848x848, Davis DR grading.
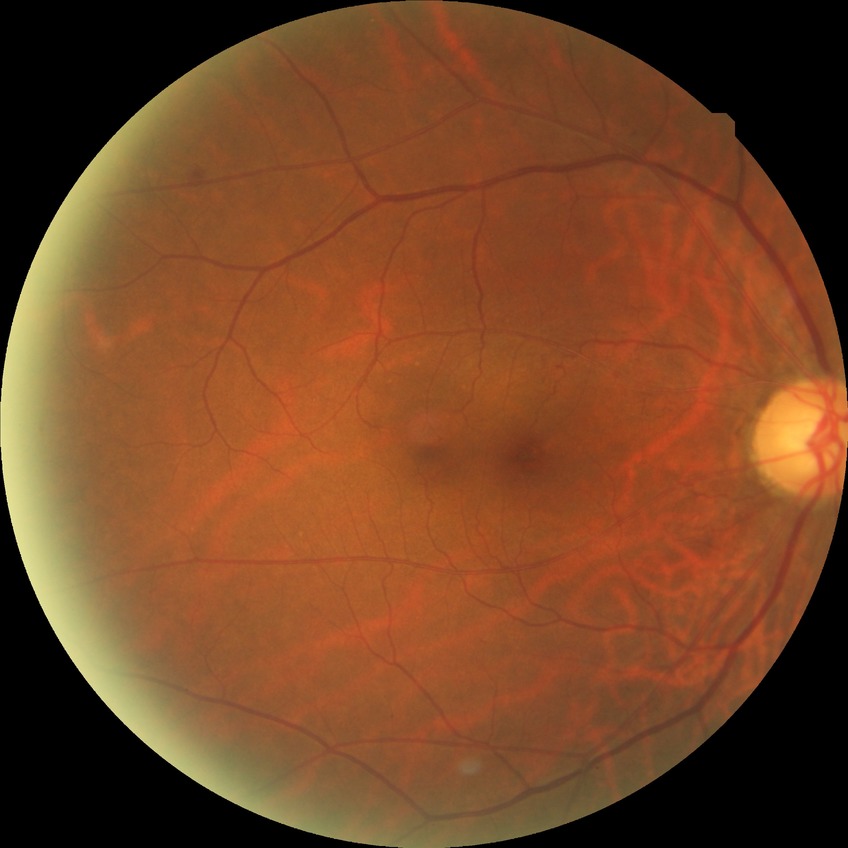 Findings:
• modified Davis classification: no diabetic retinopathy